45-degree field of view.
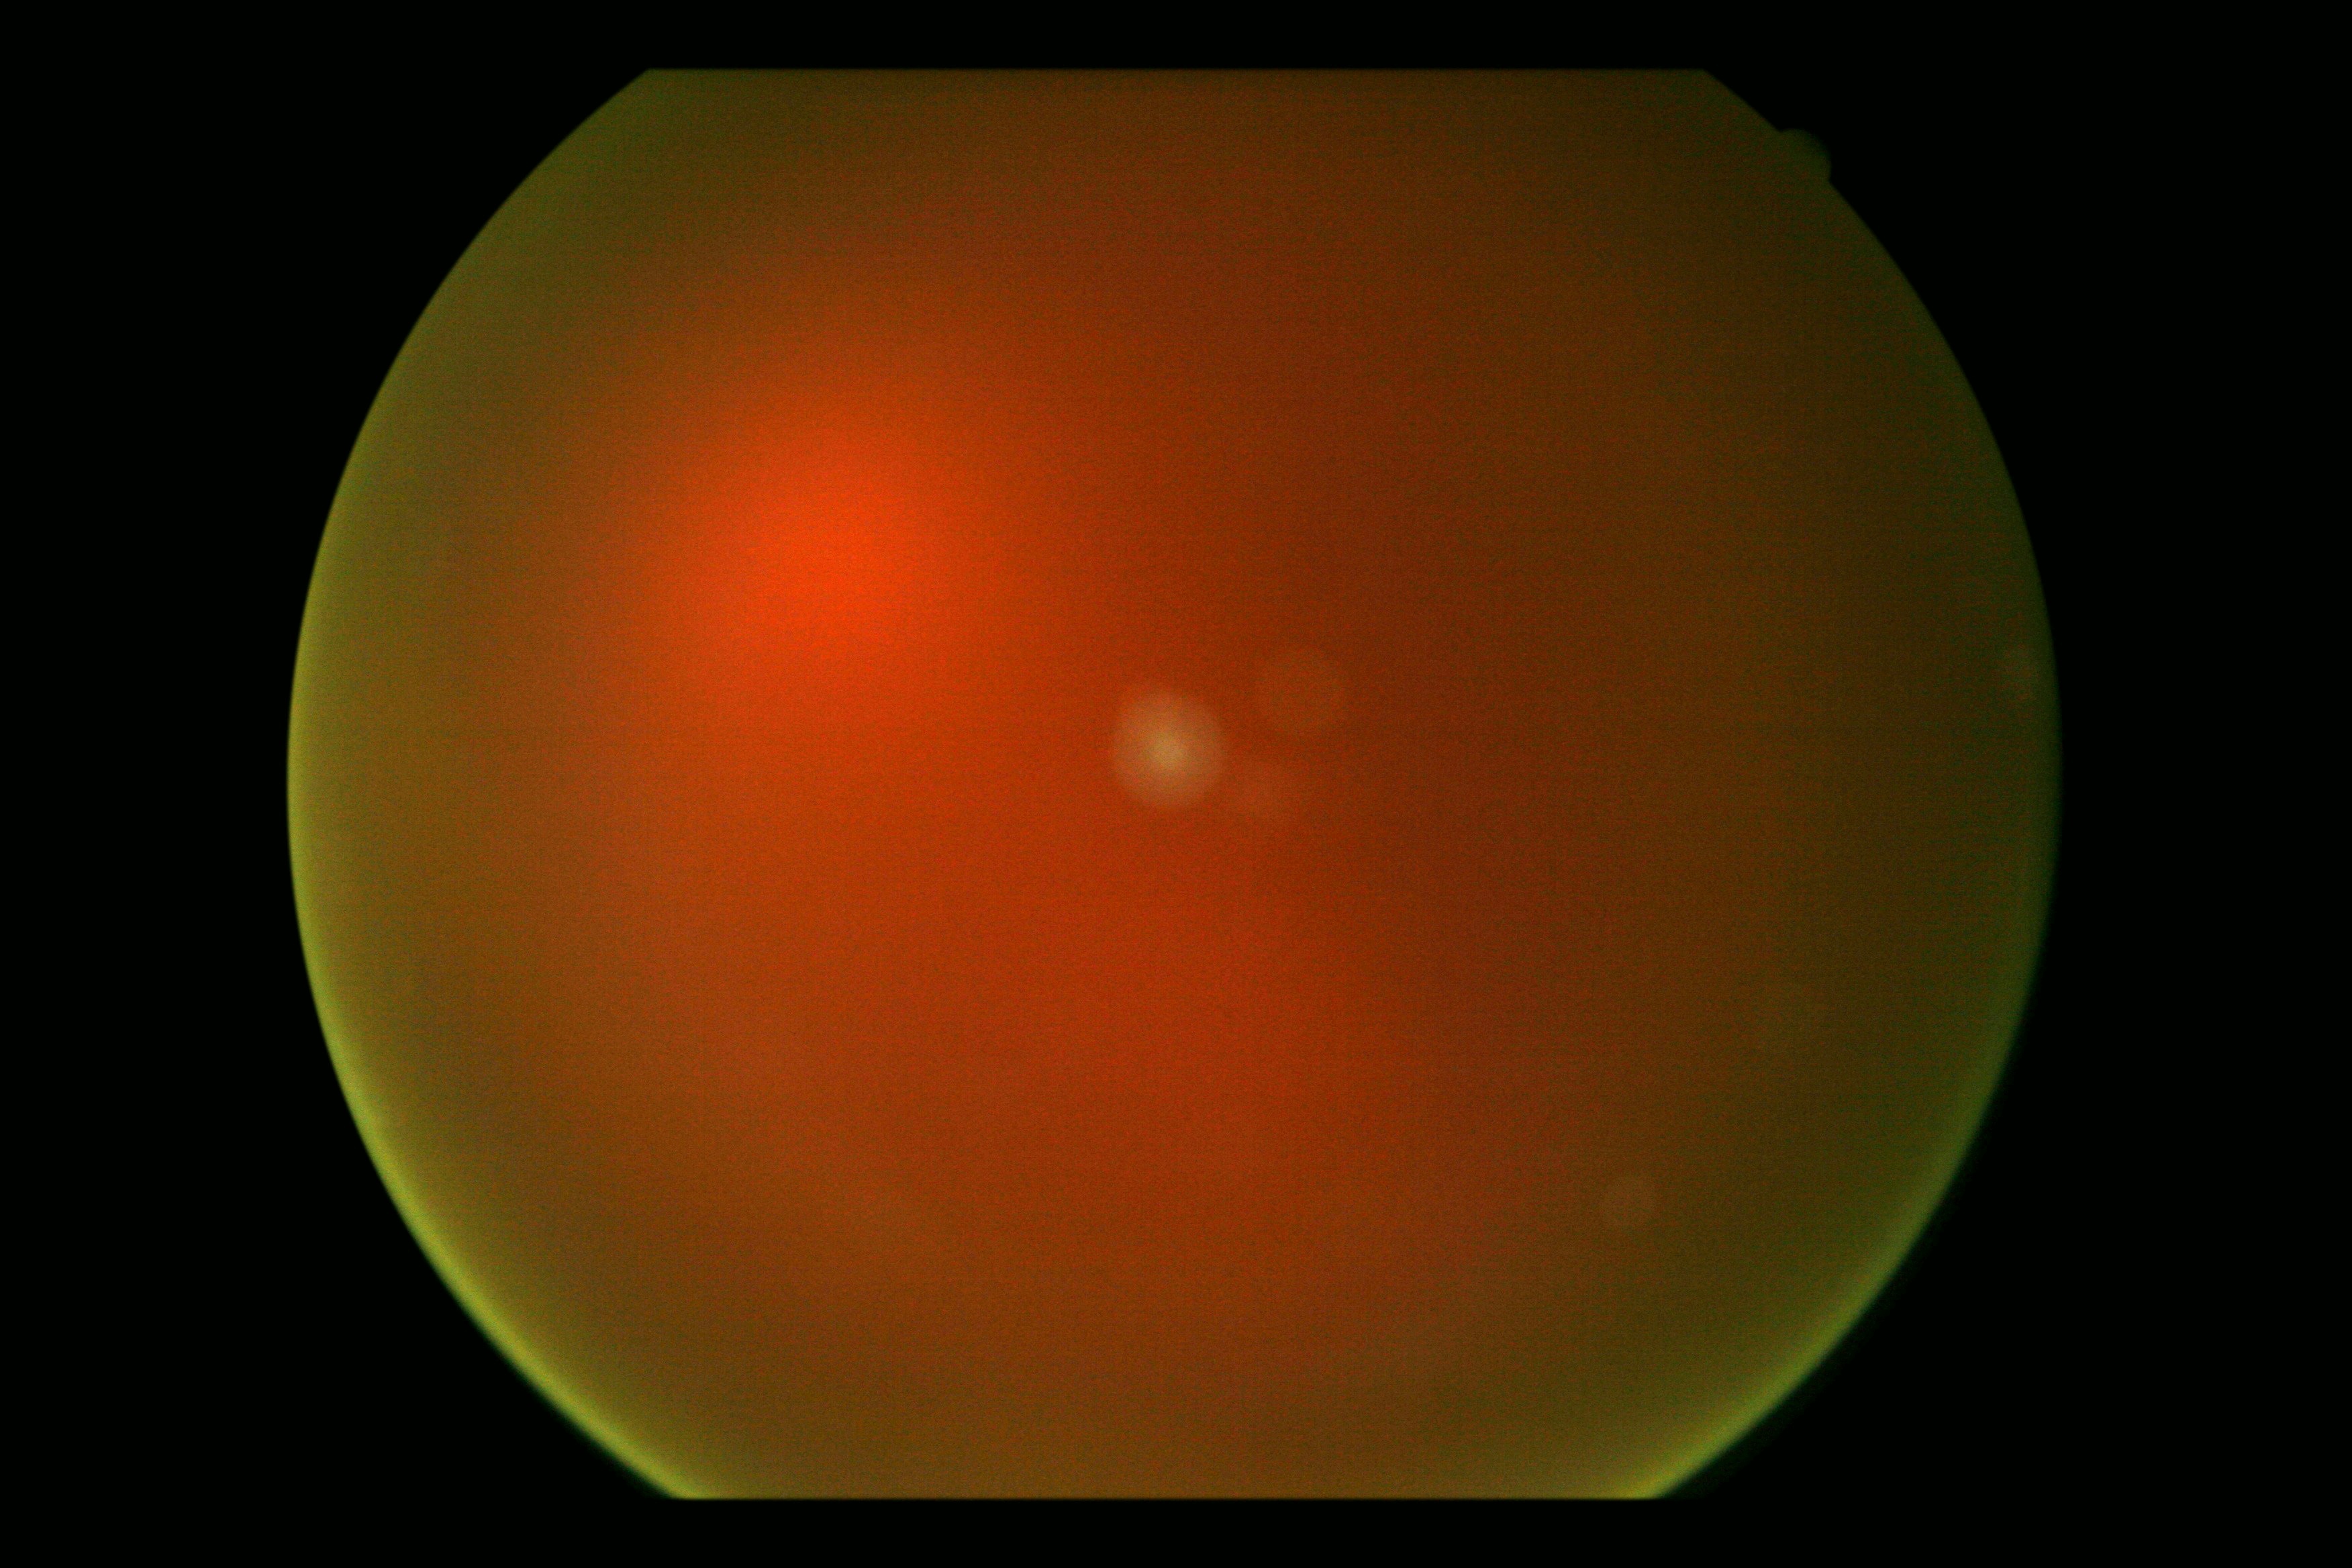   dr_grade: ungradable due to poor image quality